Camera: Remidio smartphone fundus camera.
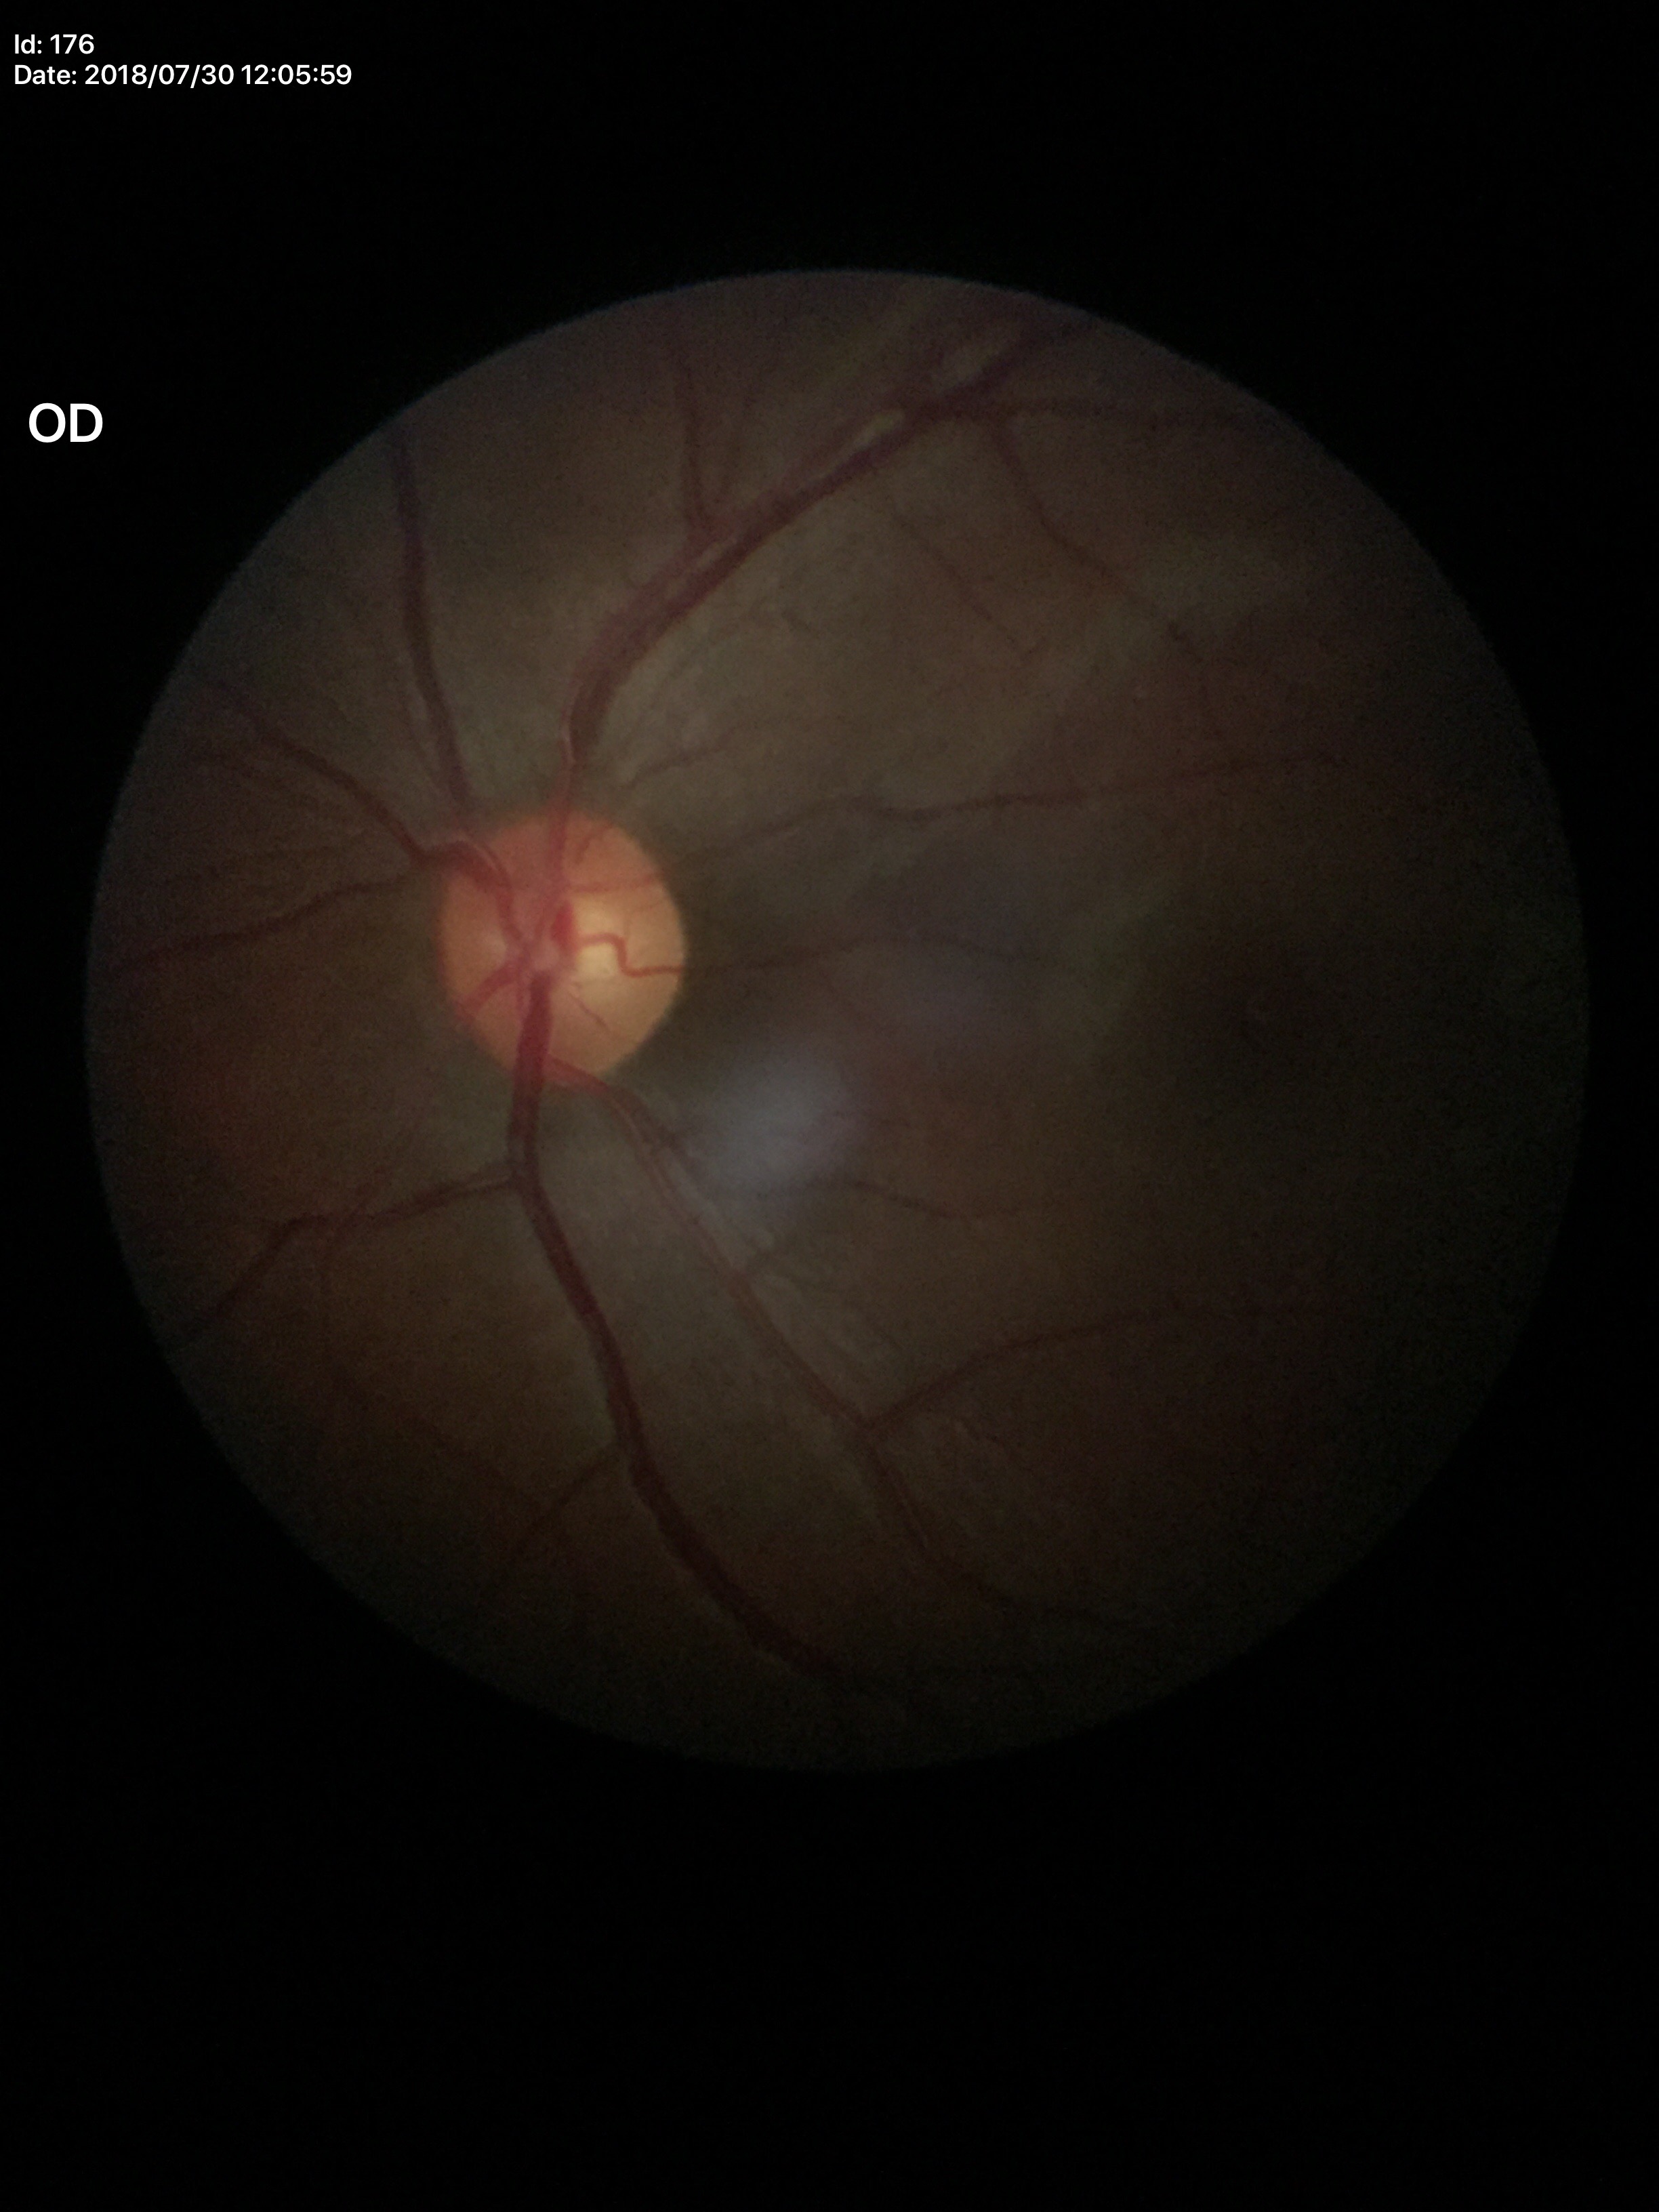

Glaucoma decision: negative.
Vertical CDR (VCDR) of 0.48.
Area cup-to-disc ratio (ACDR) of 0.25.